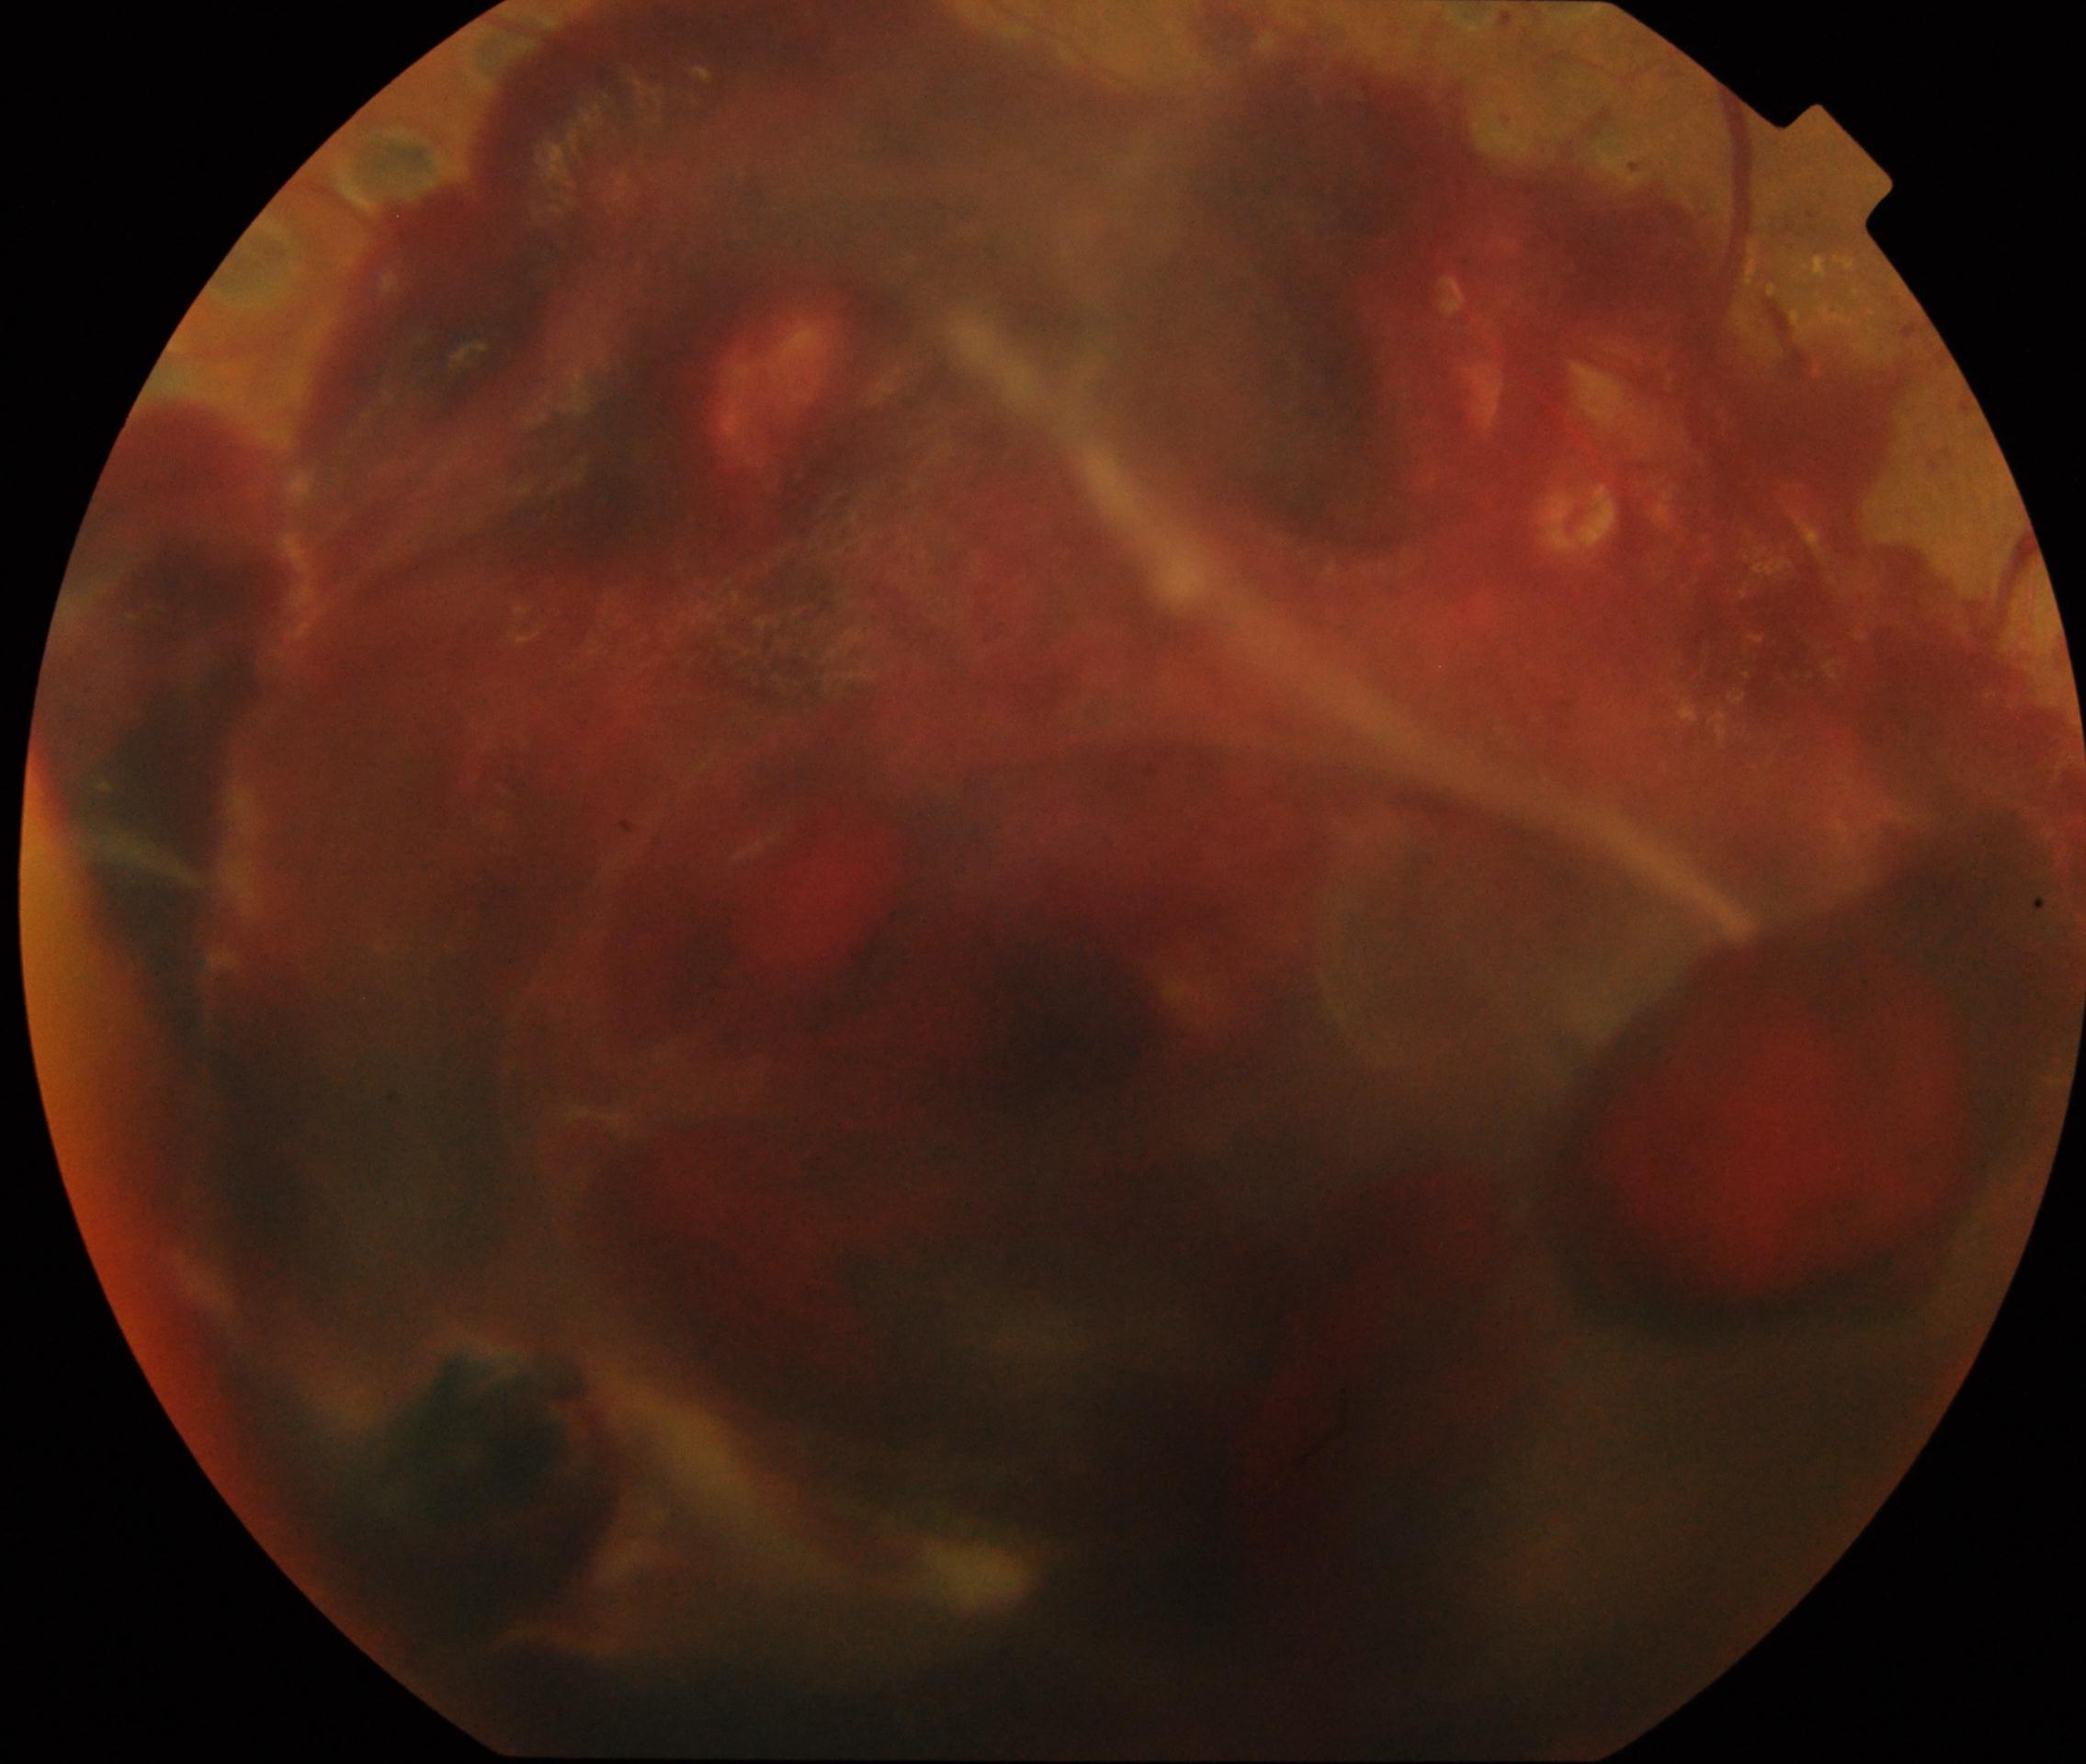
{
  "dr_grade": "4"
}